45° field of view; 2352 by 1568 pixels — 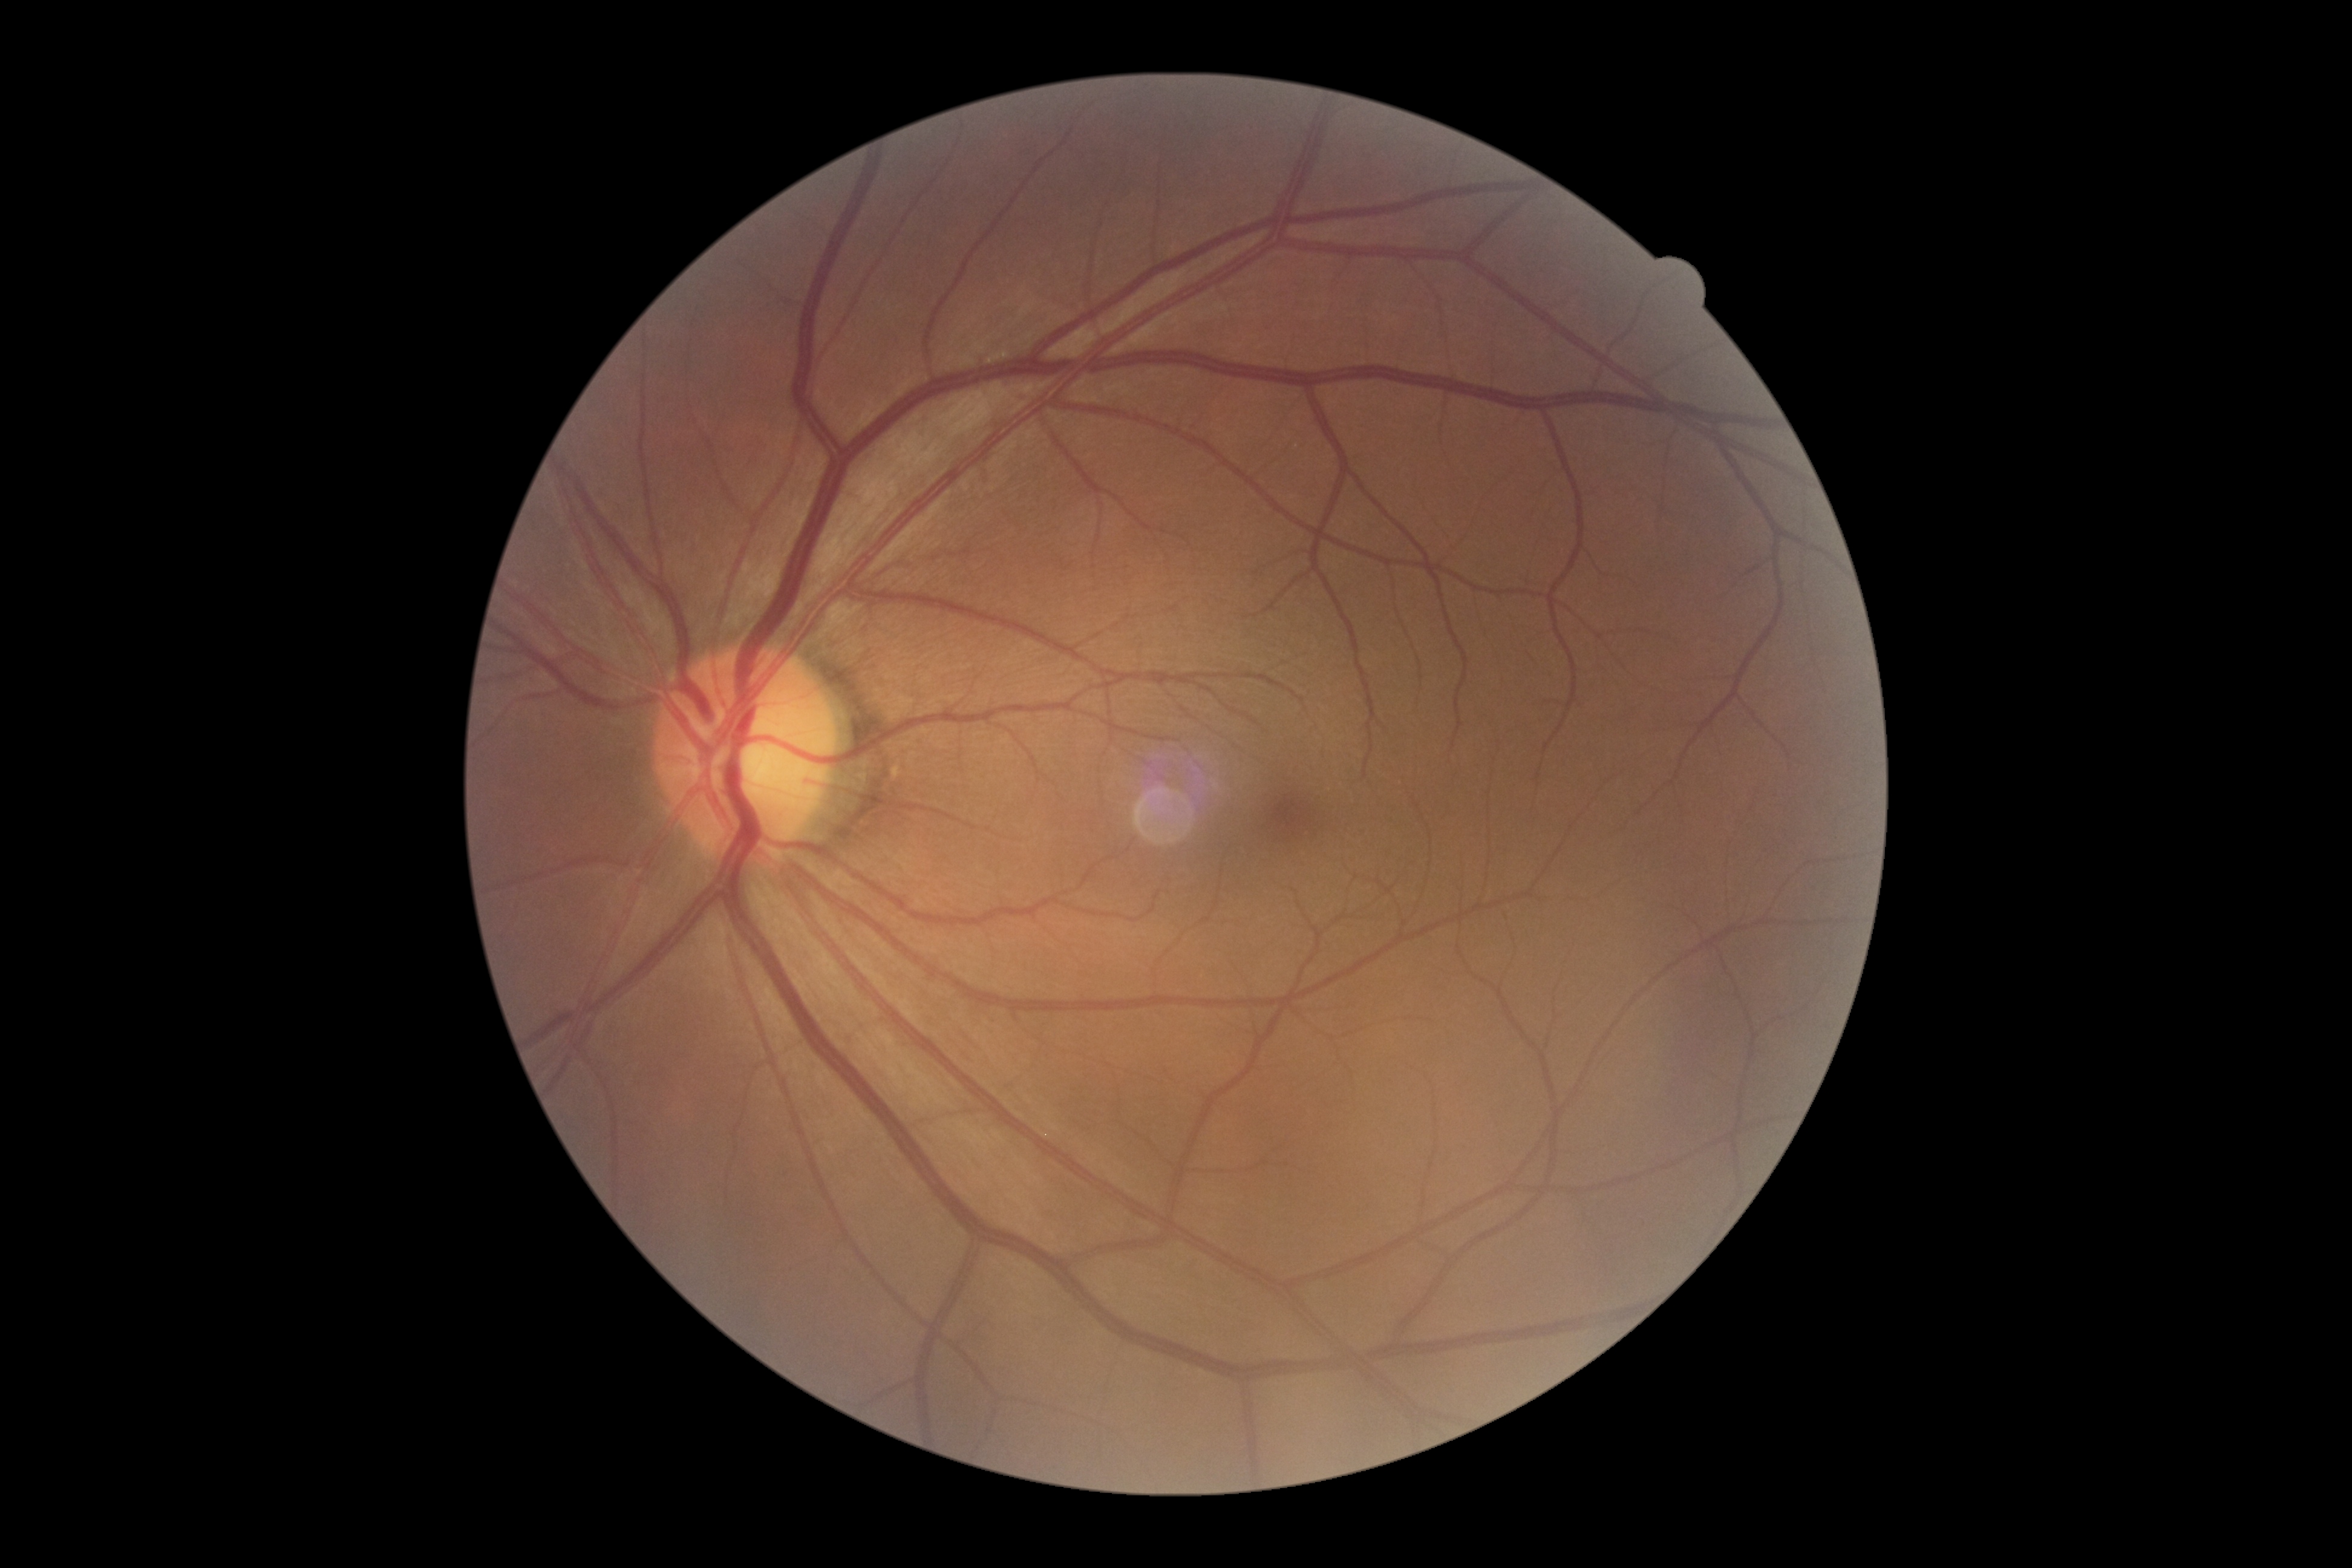
No diabetic retinal disease findings. Diabetic retinopathy is no apparent diabetic retinopathy (grade 0).